Phoenix ICON, 100° FOV · infant wide-field retinal image: 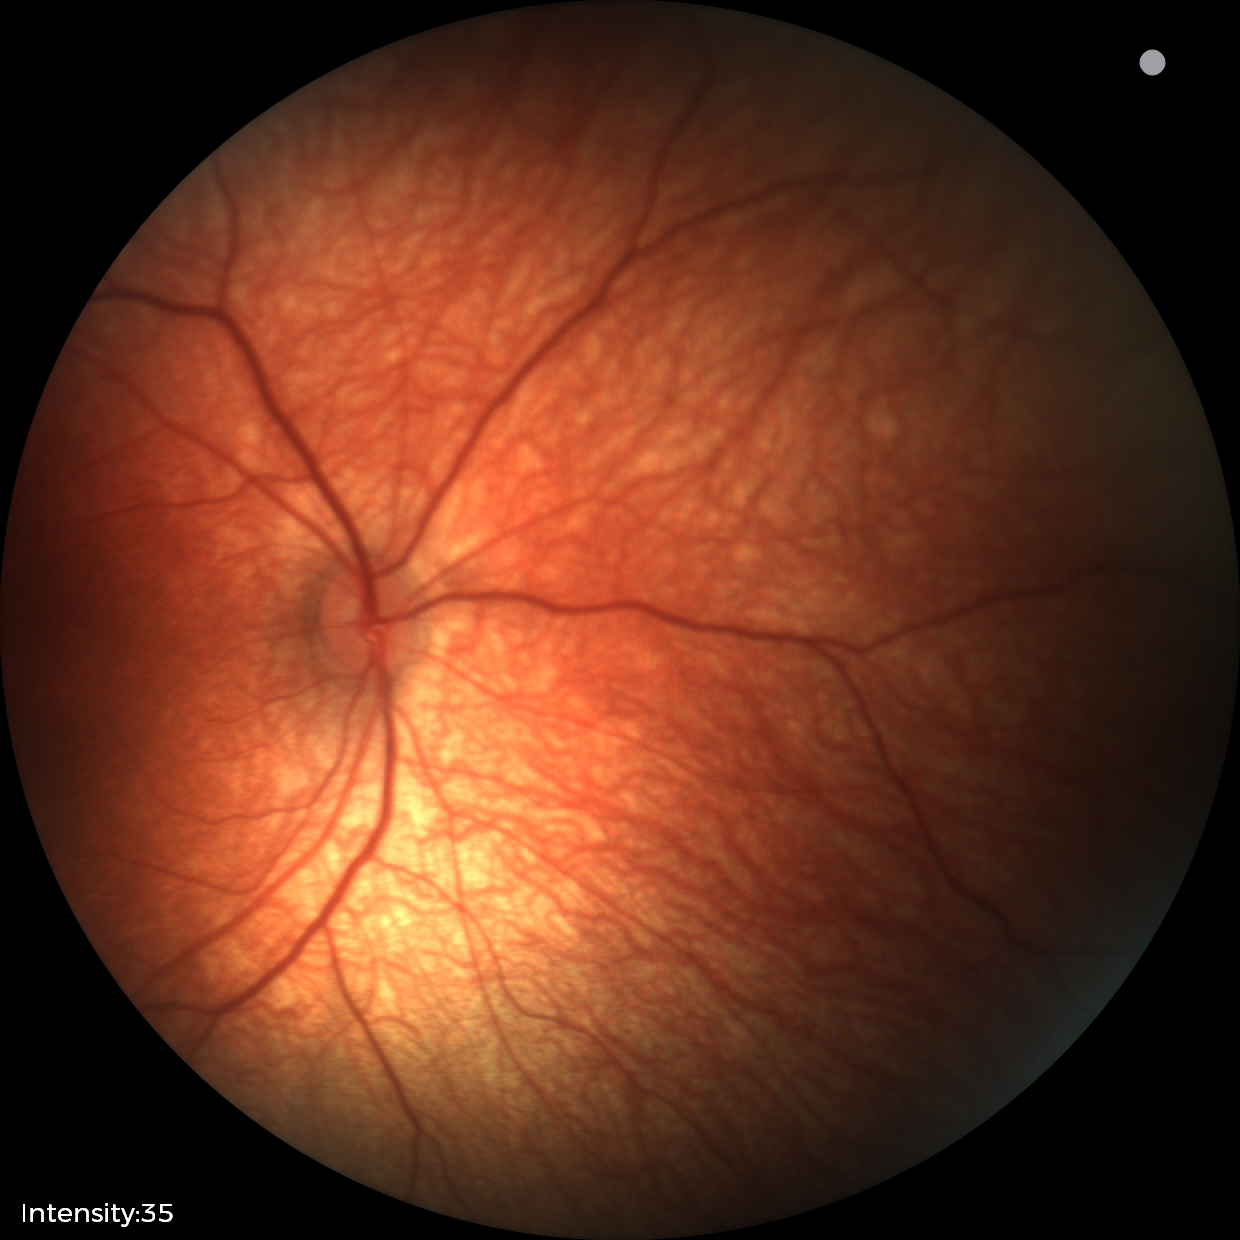 Diagnosis: normal retinal appearance.